Ultra-widefield (UWF) fundus image; 200° field of view: 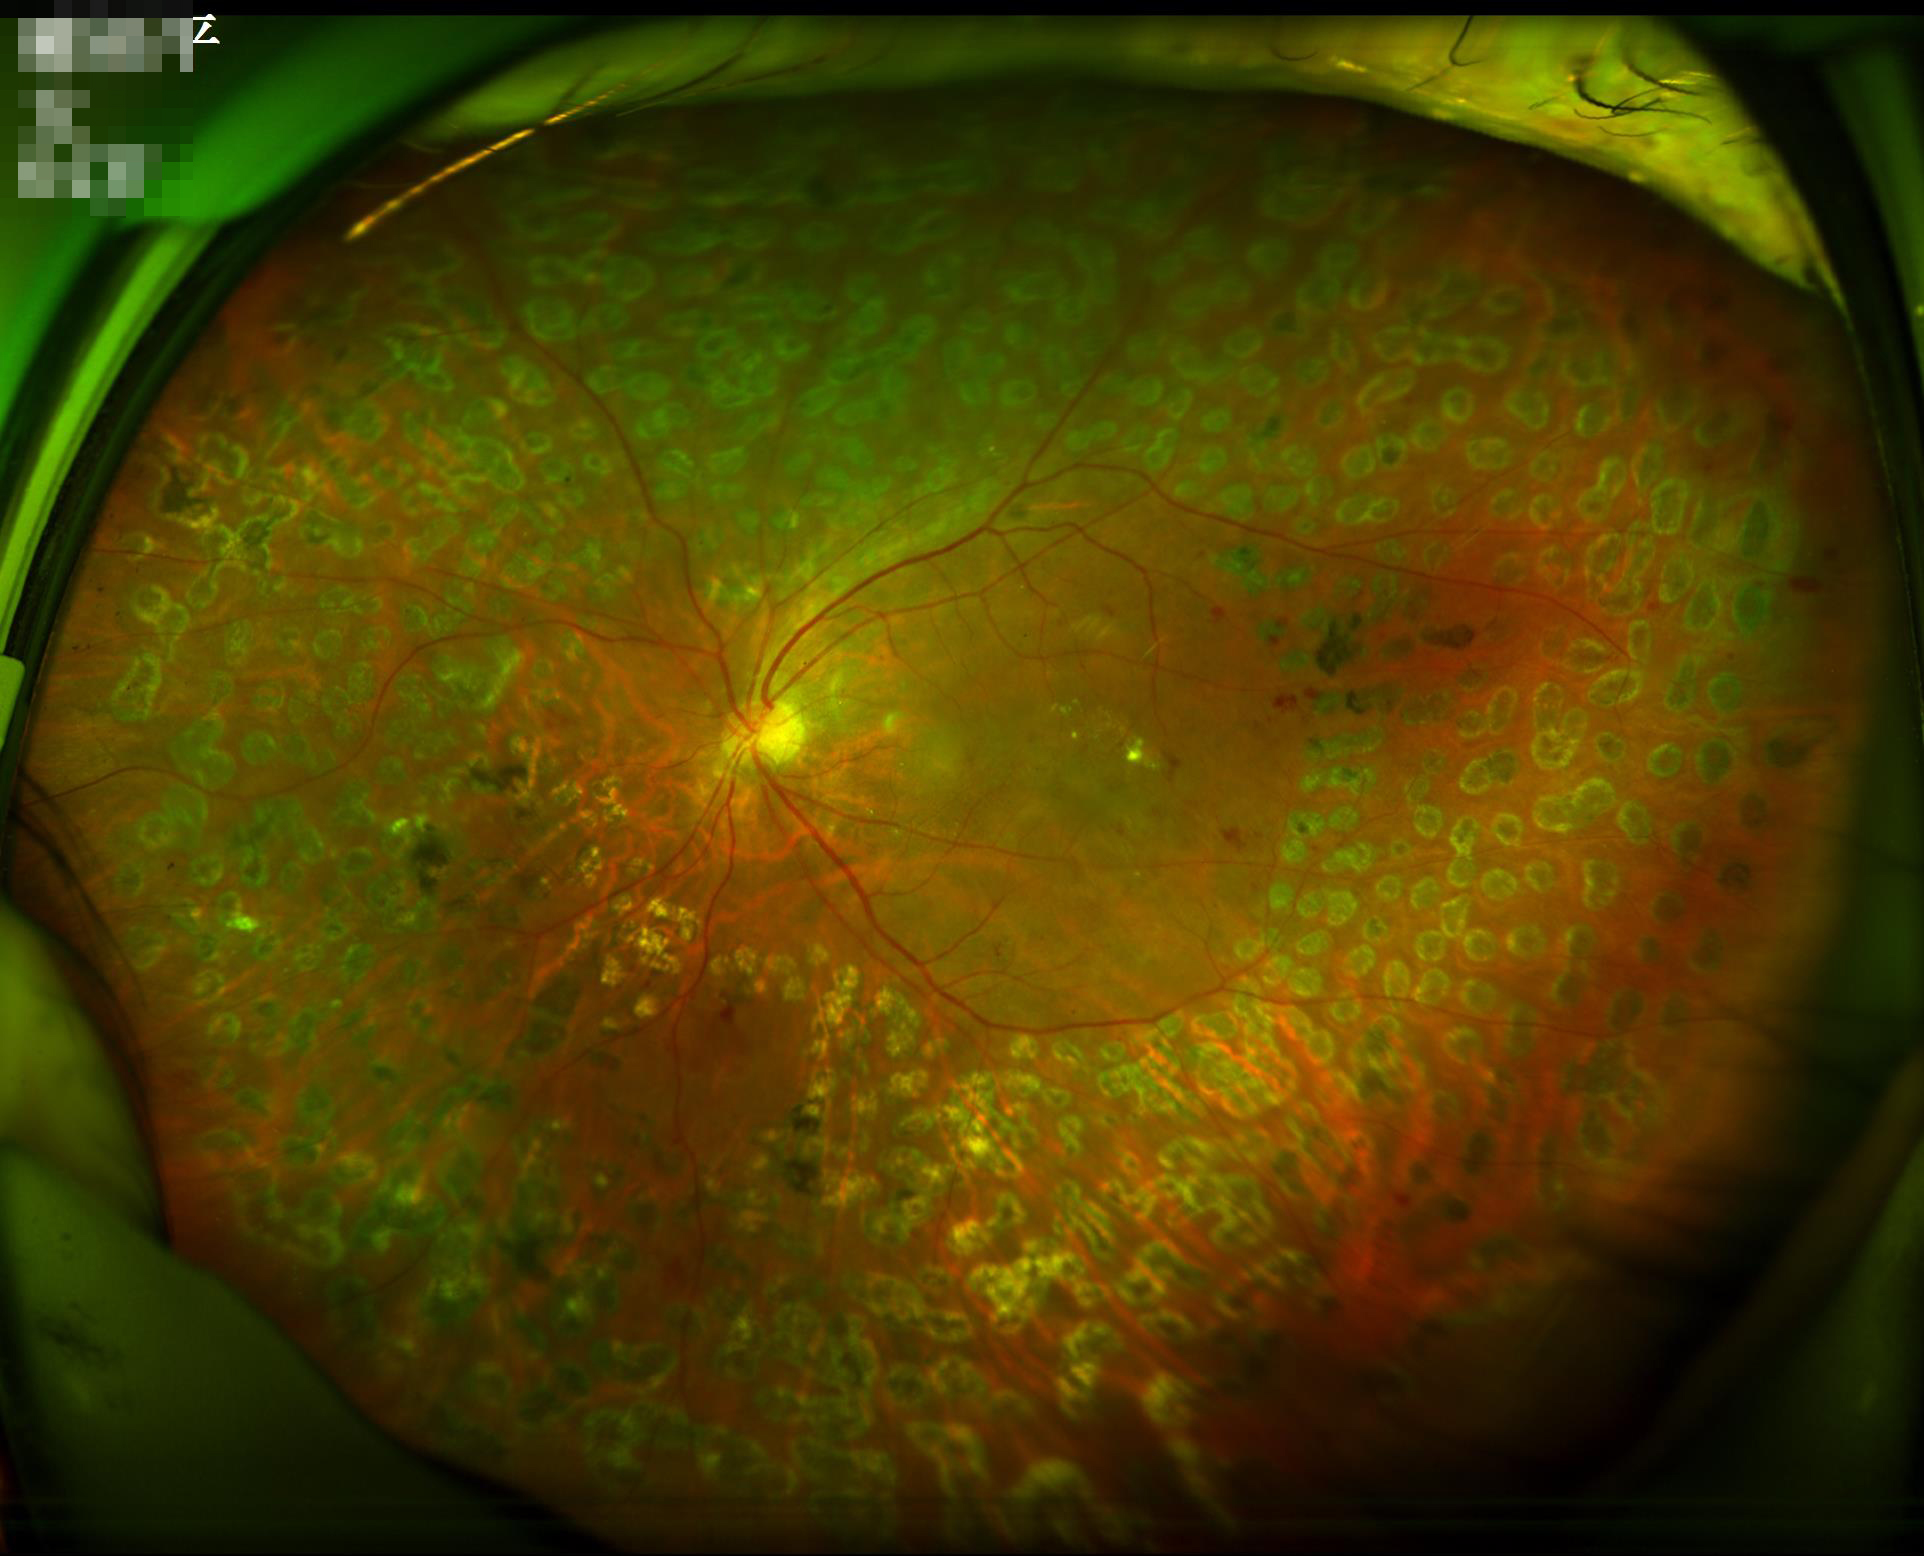
contrast: satisfactory
clarity: sharp
overall_quality: acceptable
illumination: good